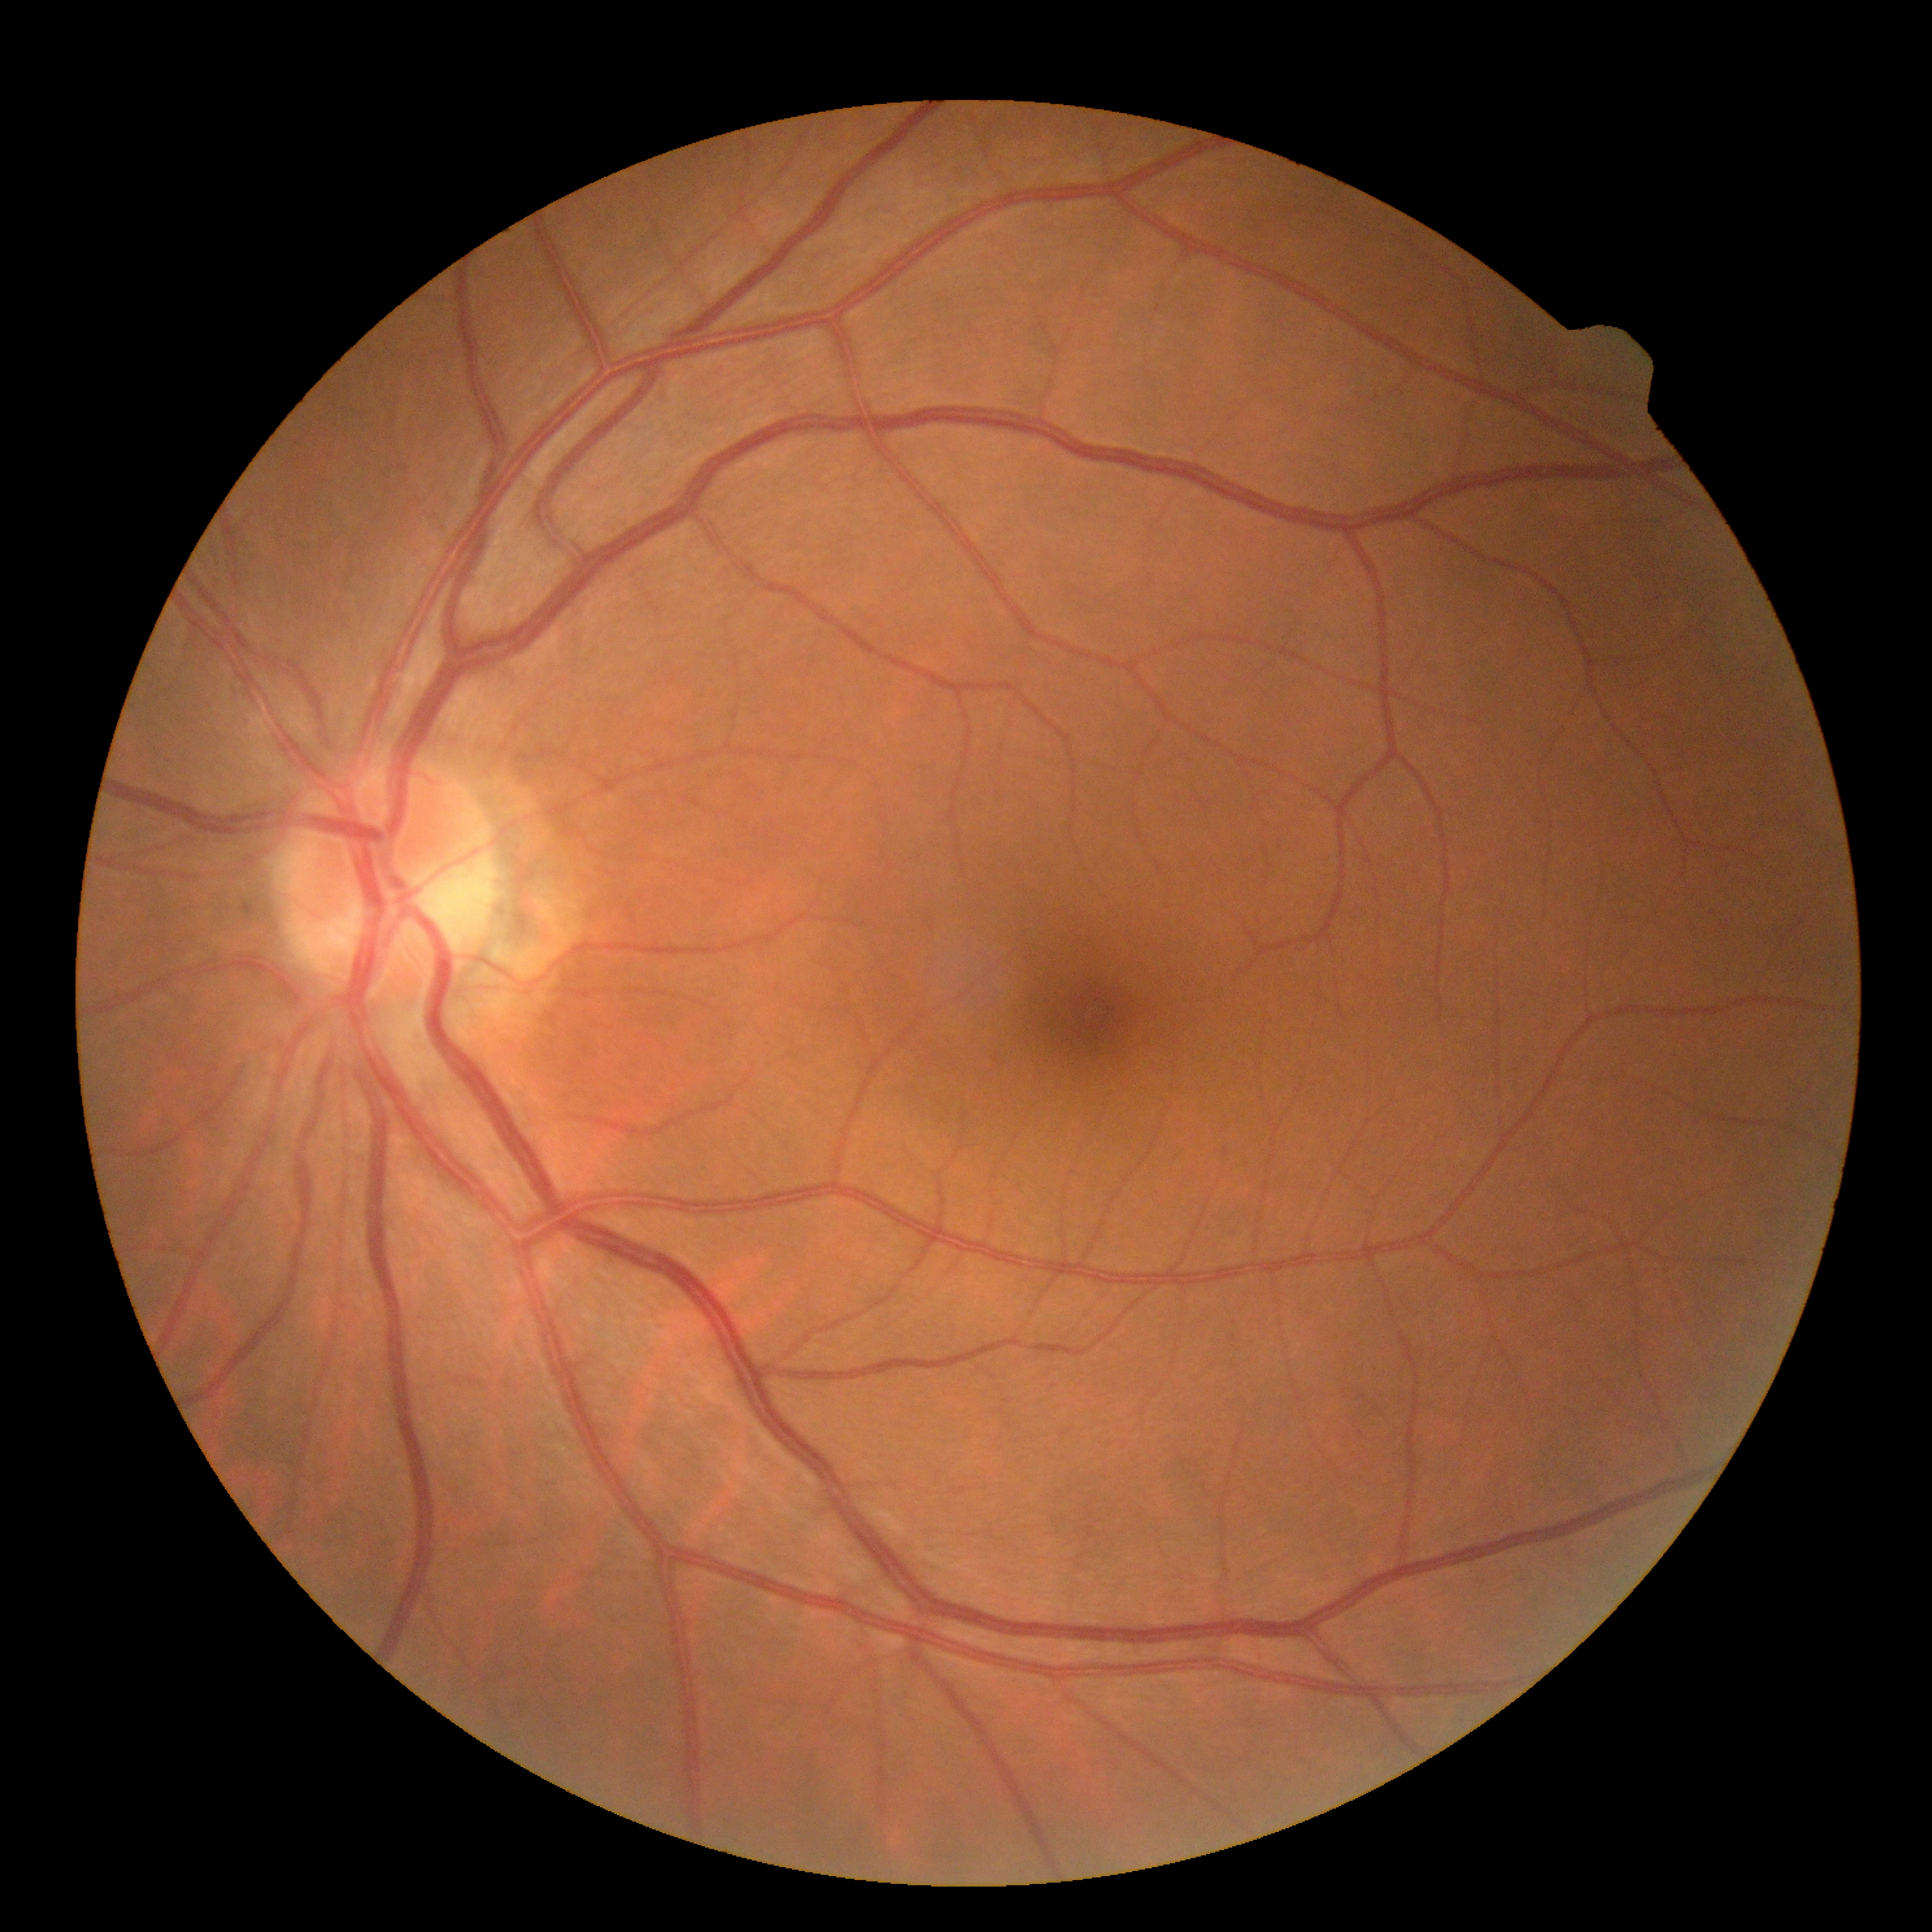 diabetic retinopathy grade = 0 (no apparent retinopathy).